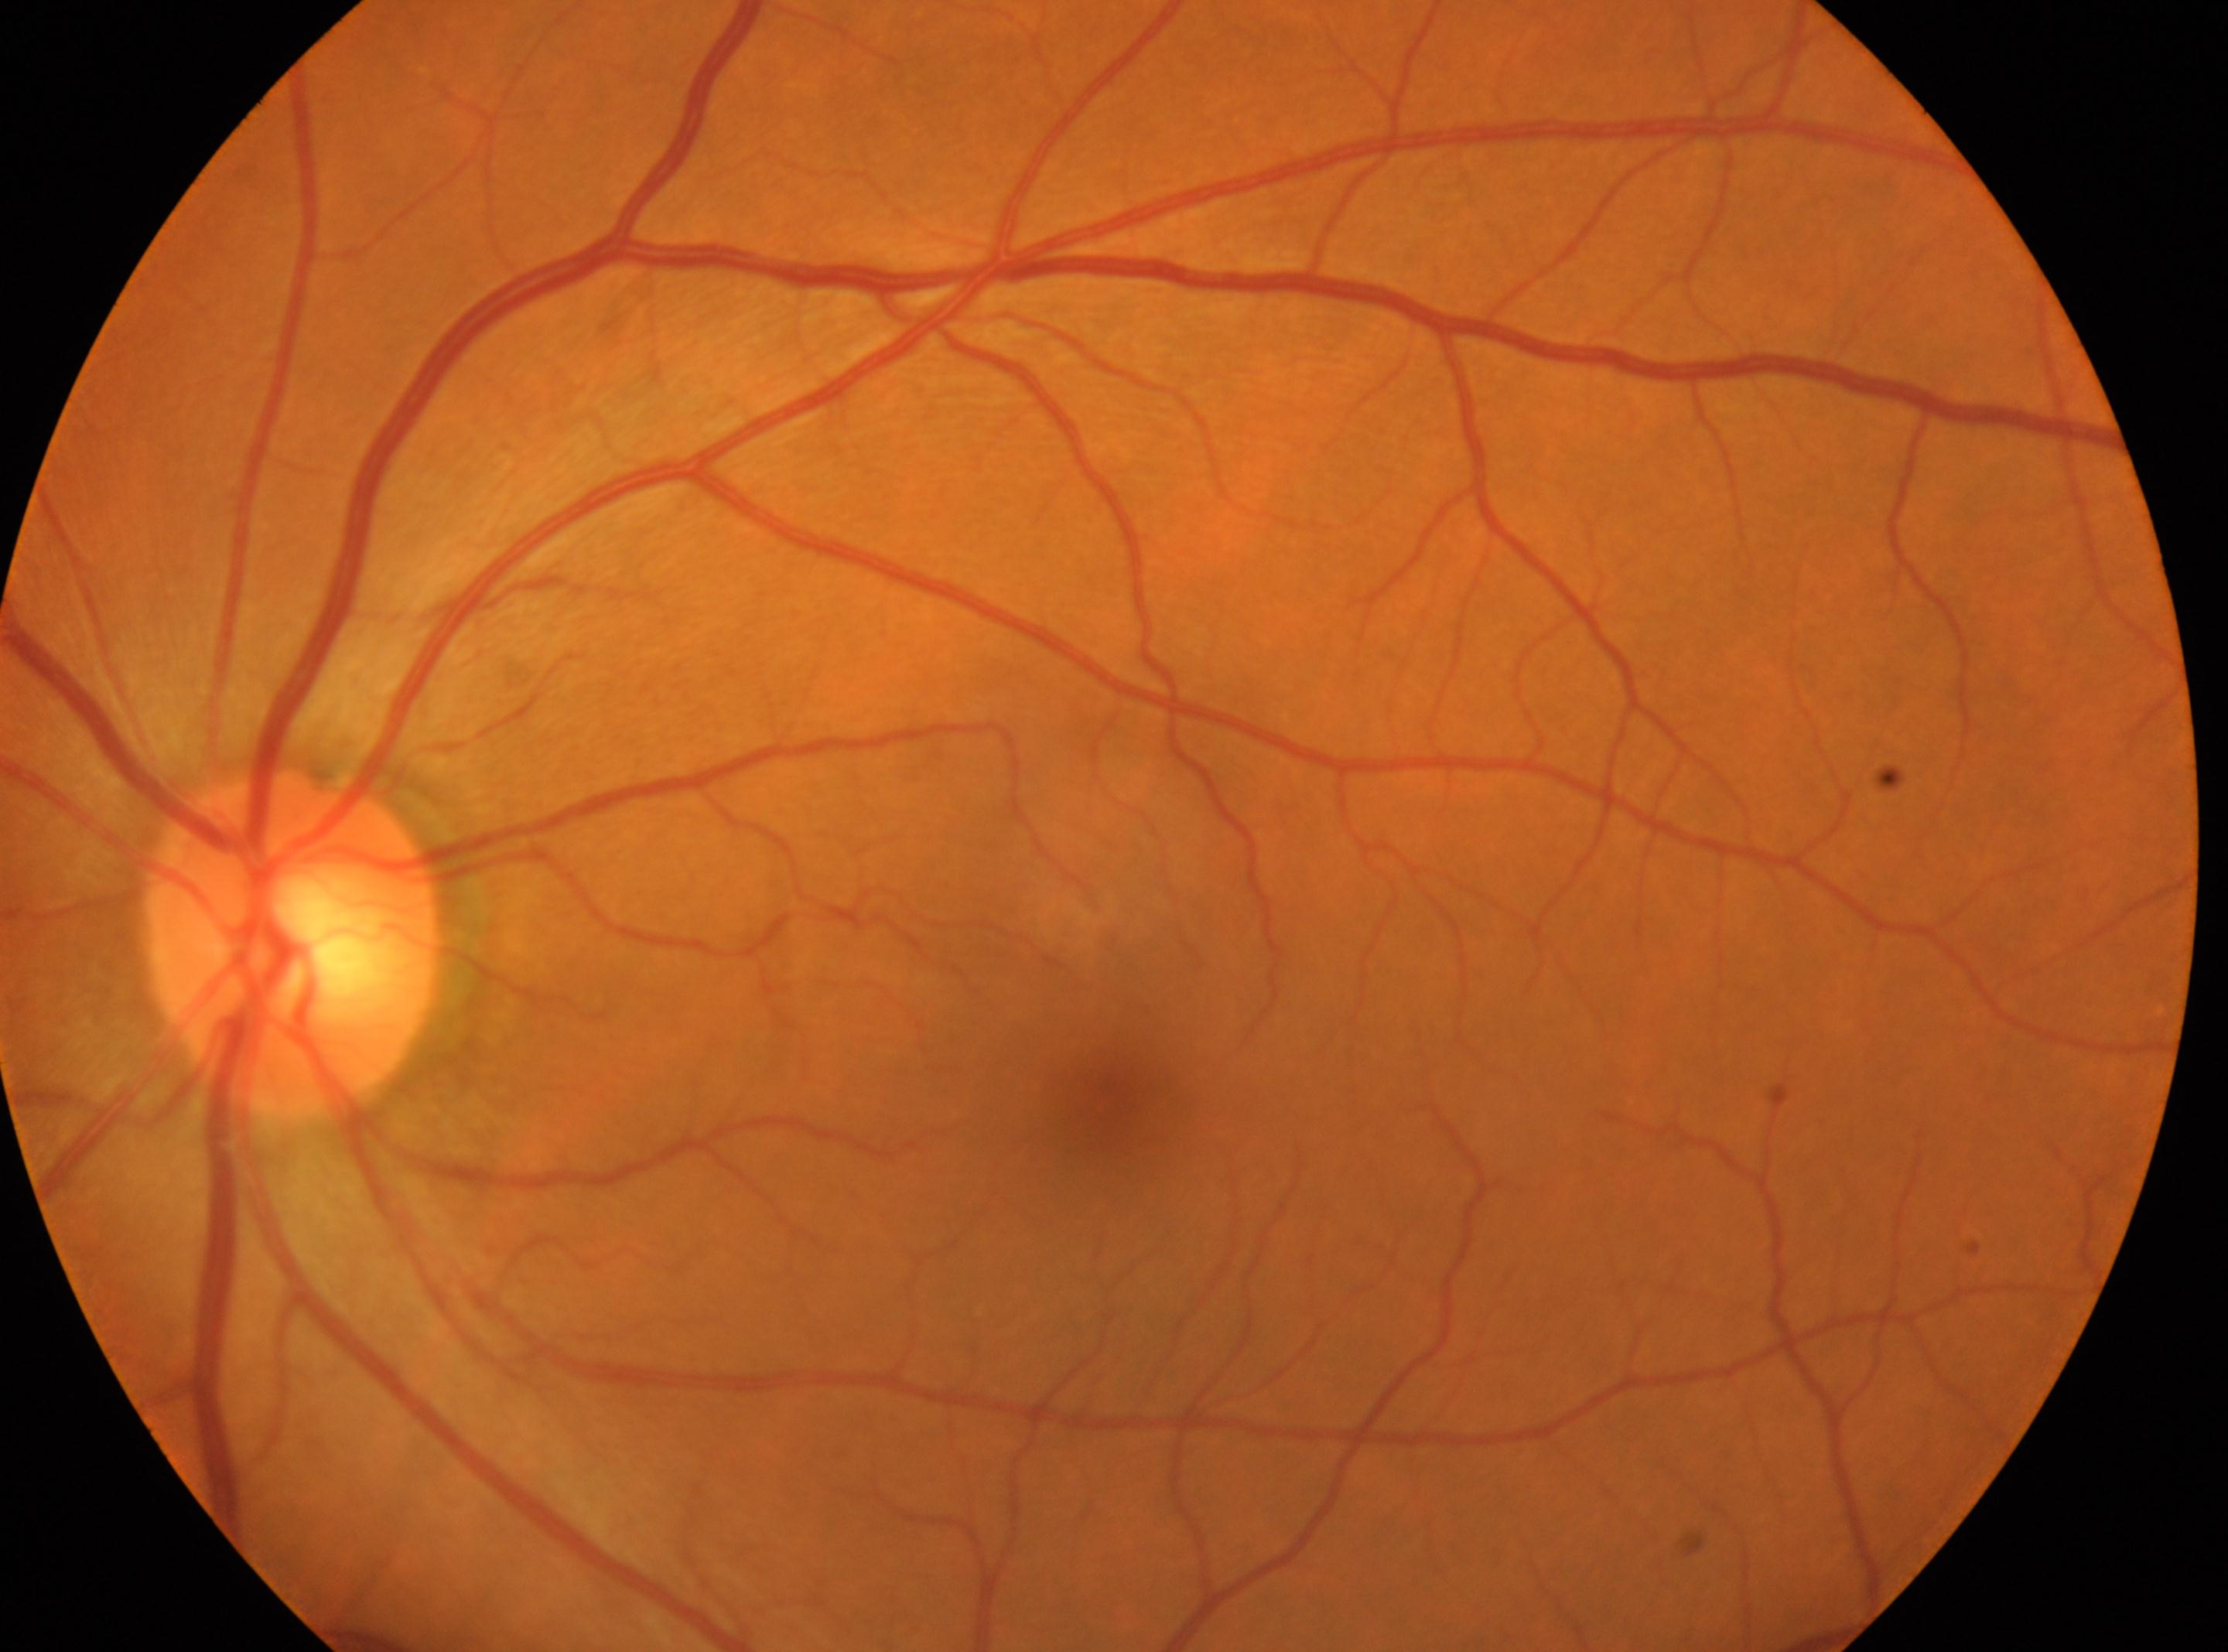

* DR impression — No DR findings
* fovea — [1105, 1098]
* DR severity — 0/4
* optic disc — [293, 945]
* laterality — left eye